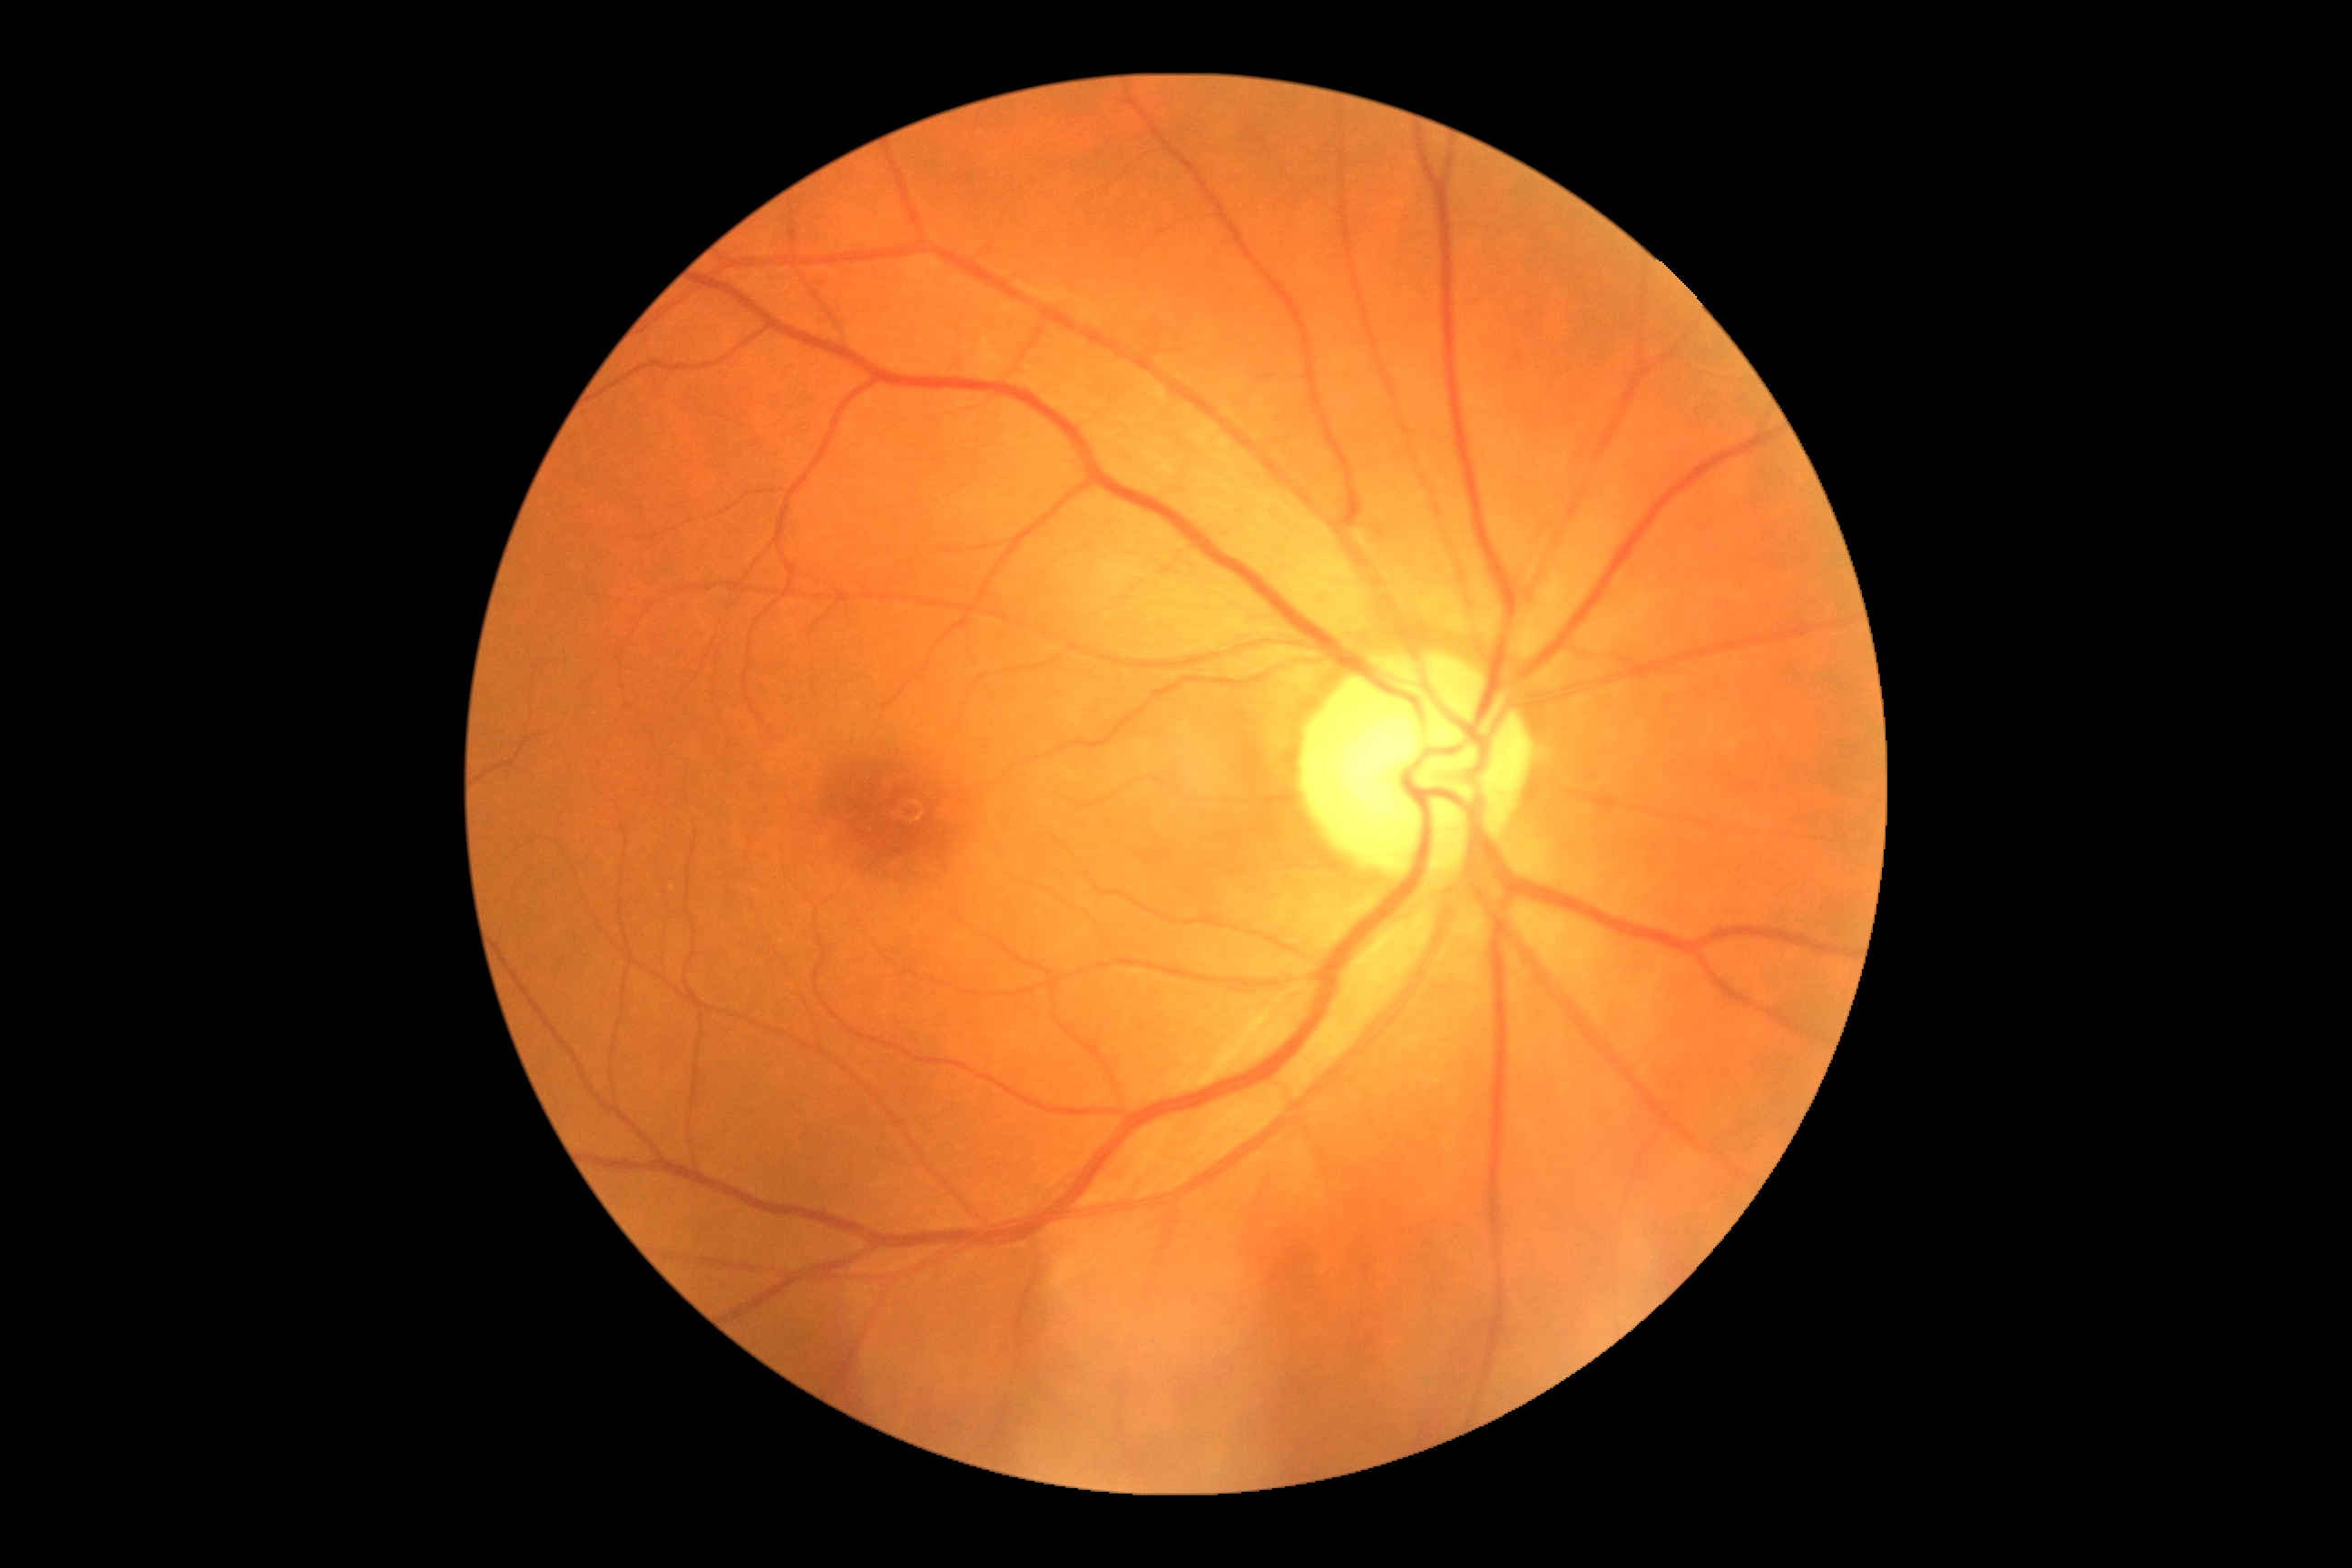

retinopathy grade@no apparent retinopathy (0).